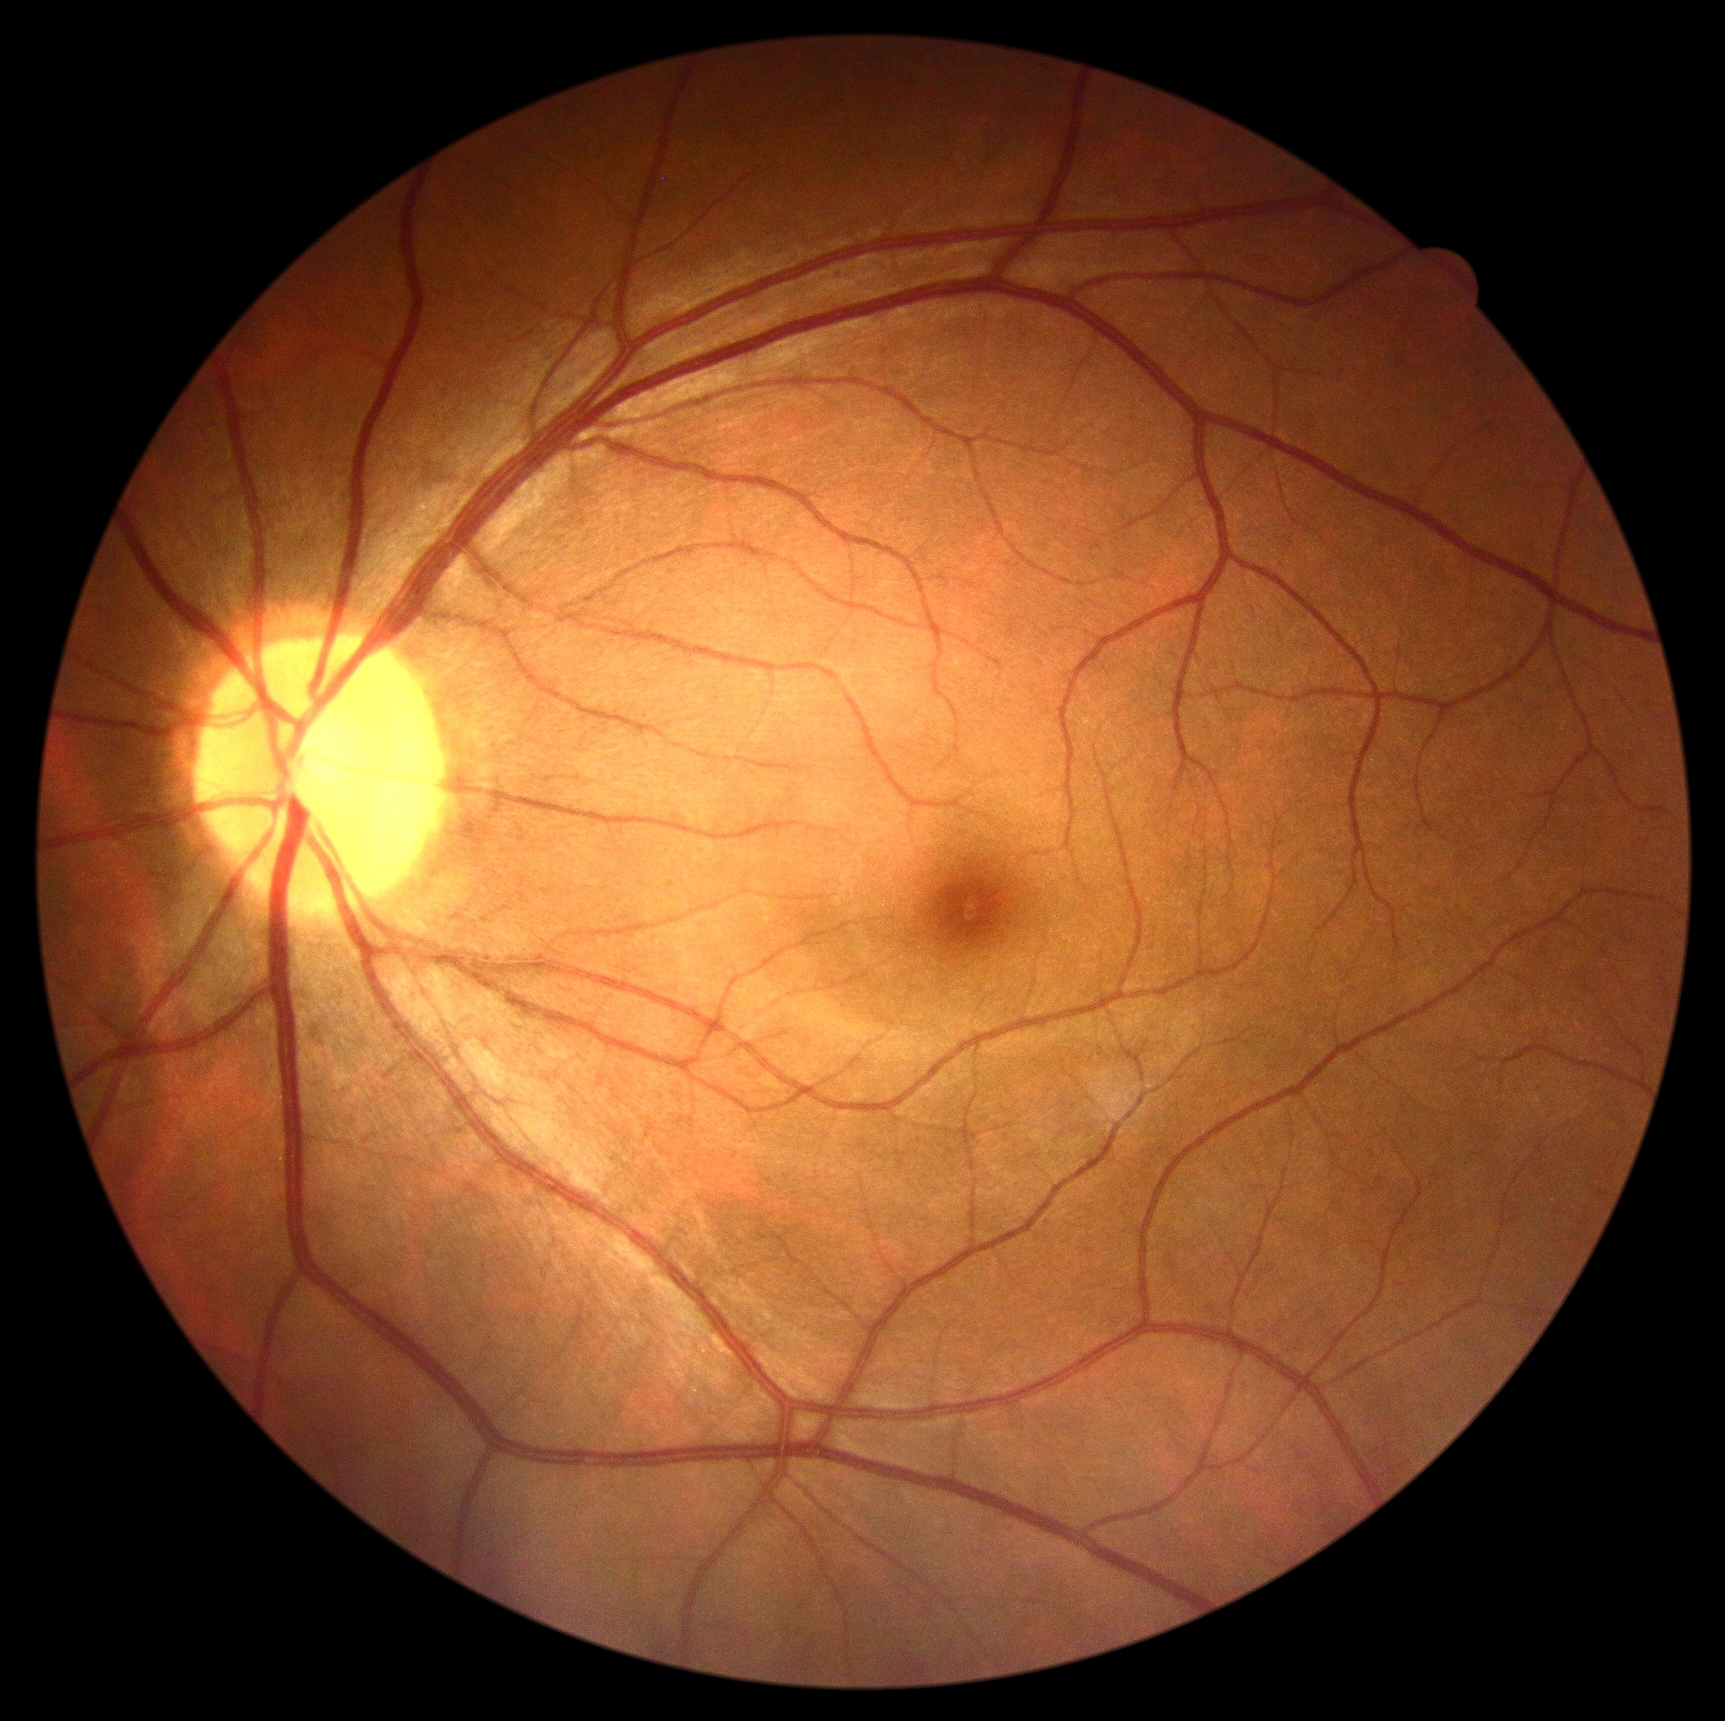

diabetic retinopathy (DR)@grade 0.